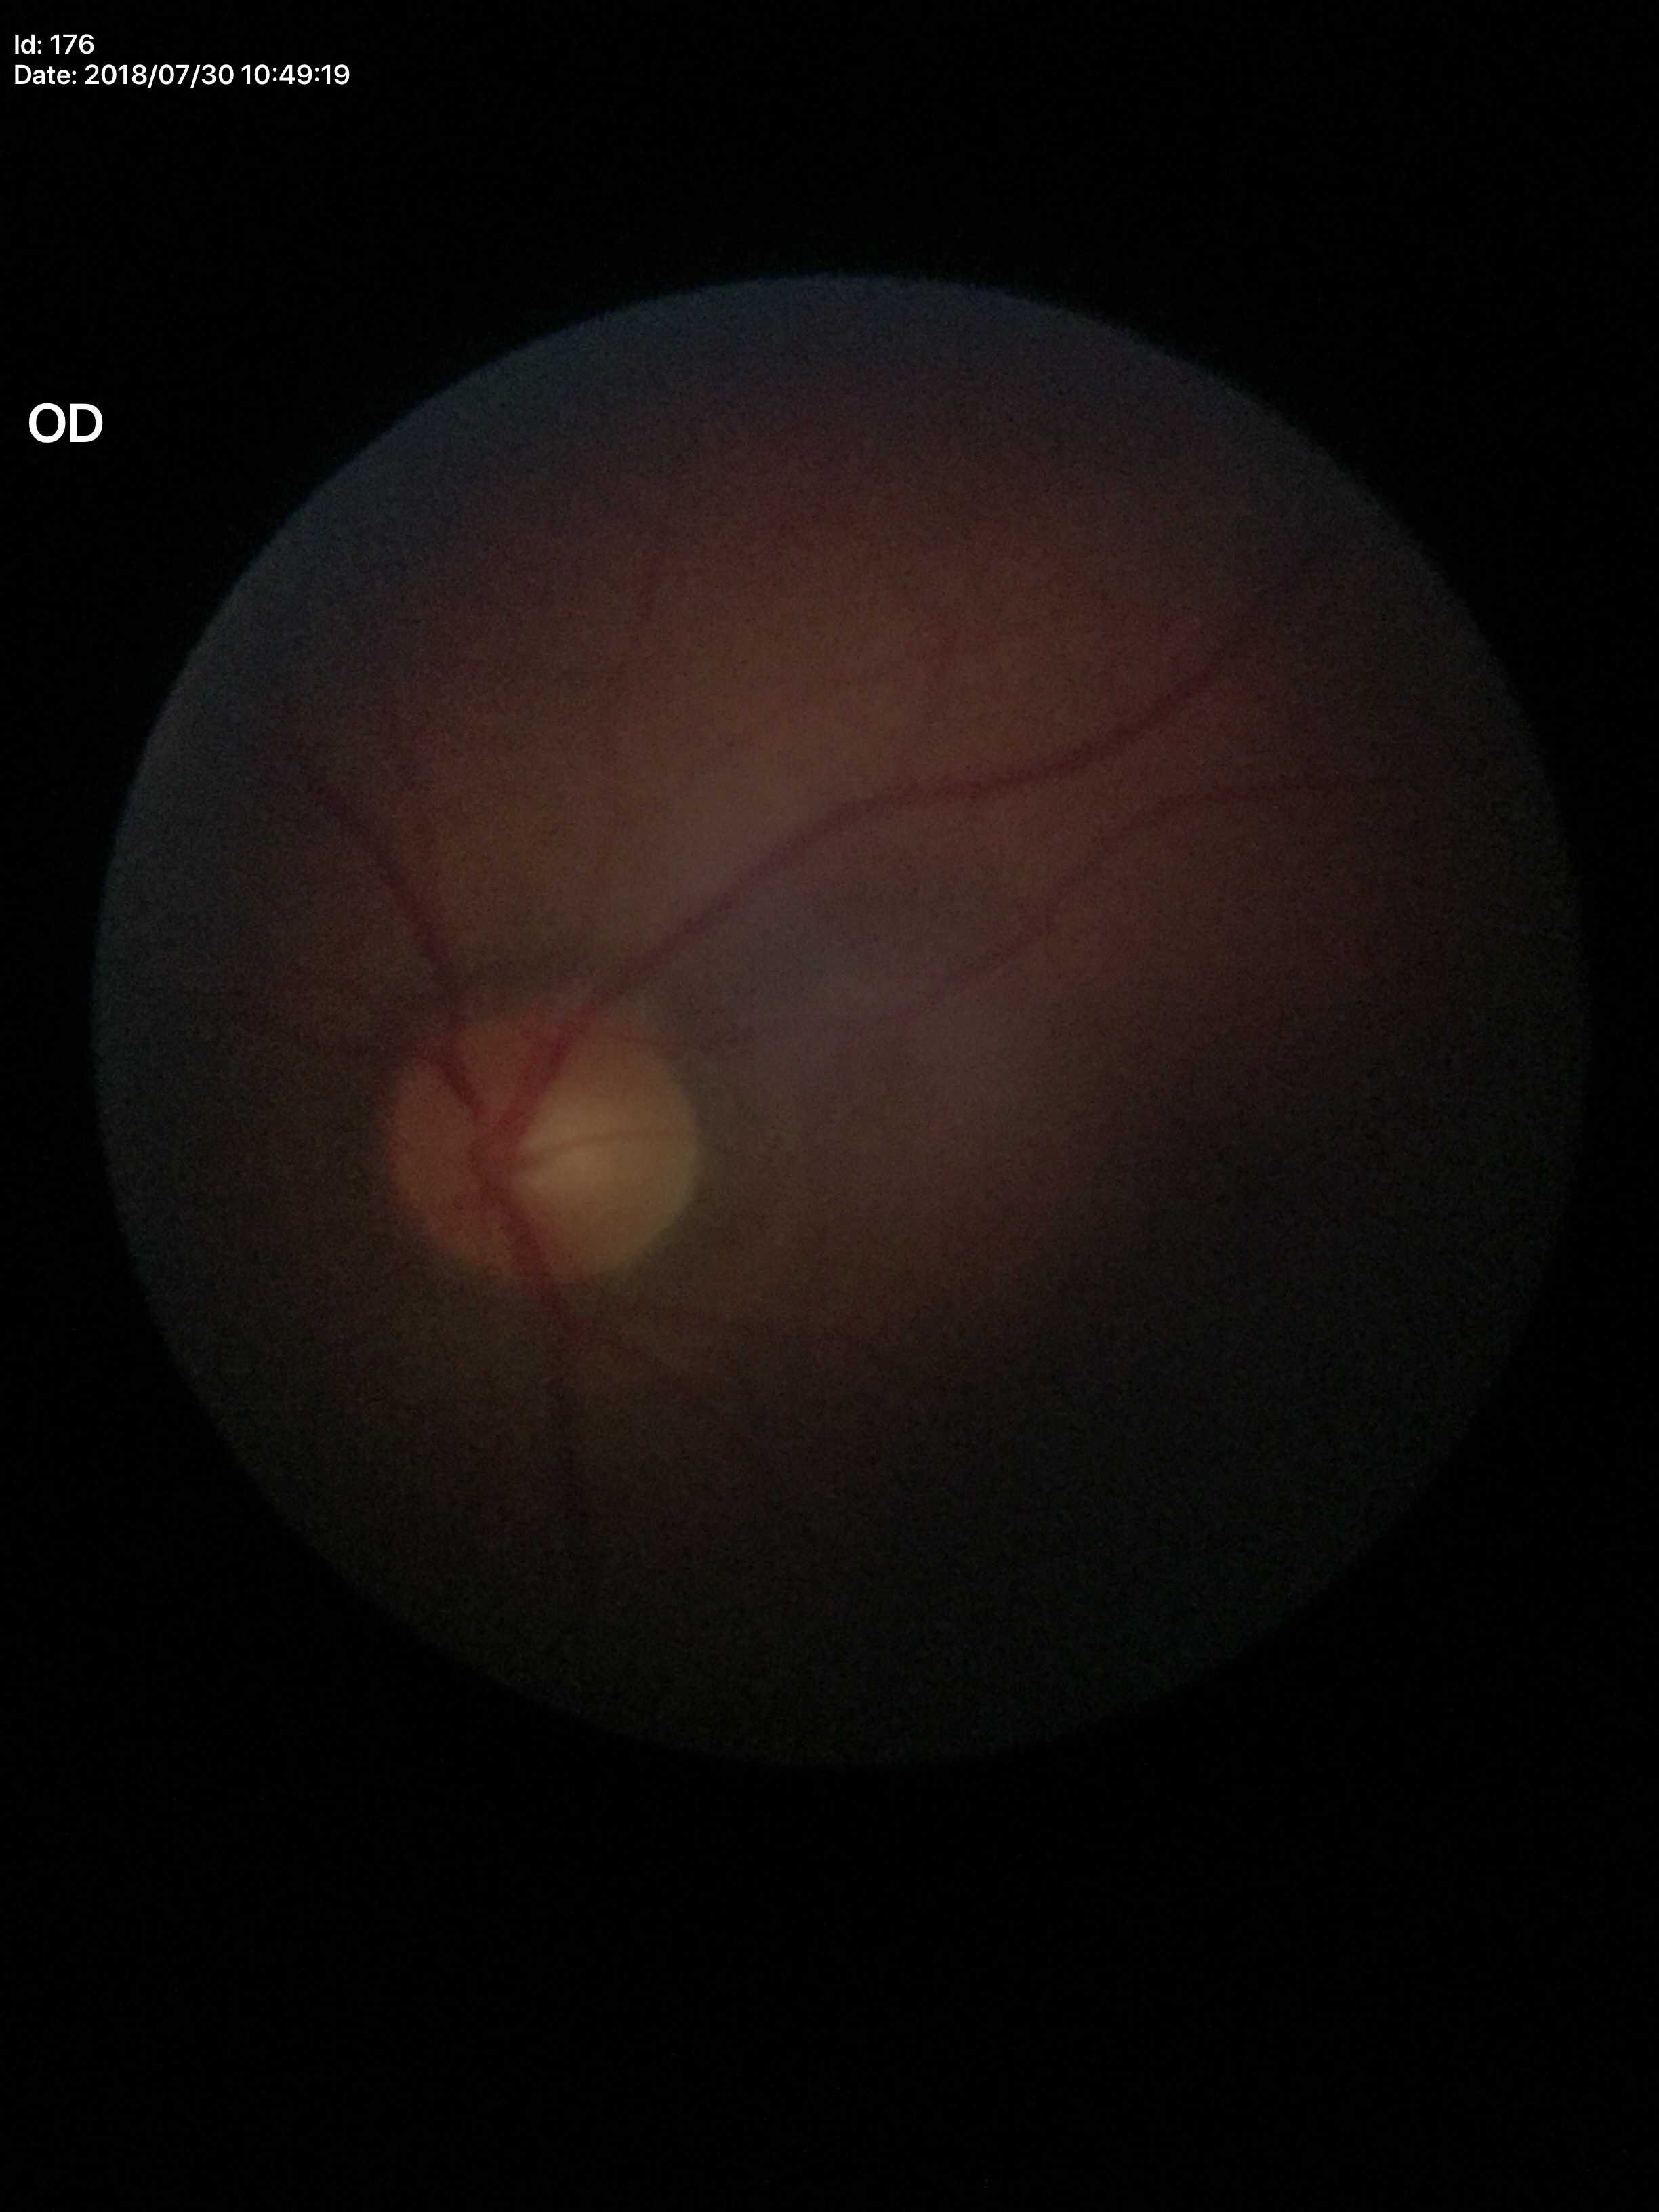
Glaucoma screening: negative.
VCDR: 0.50.